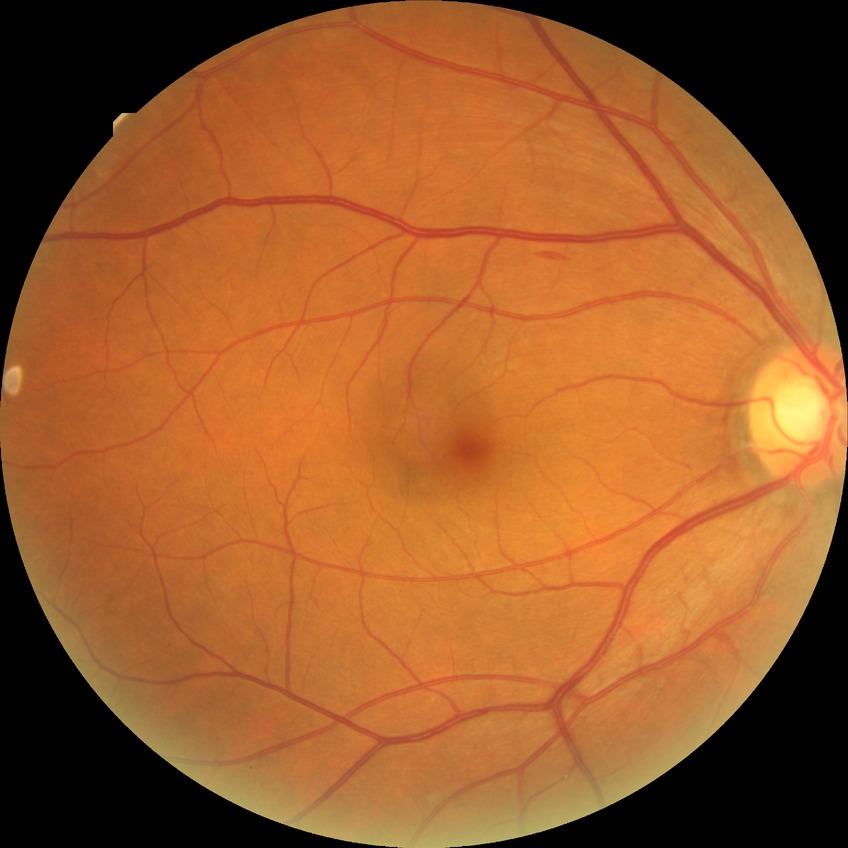
diabetic retinopathy (DR): SDR (simple diabetic retinopathy)